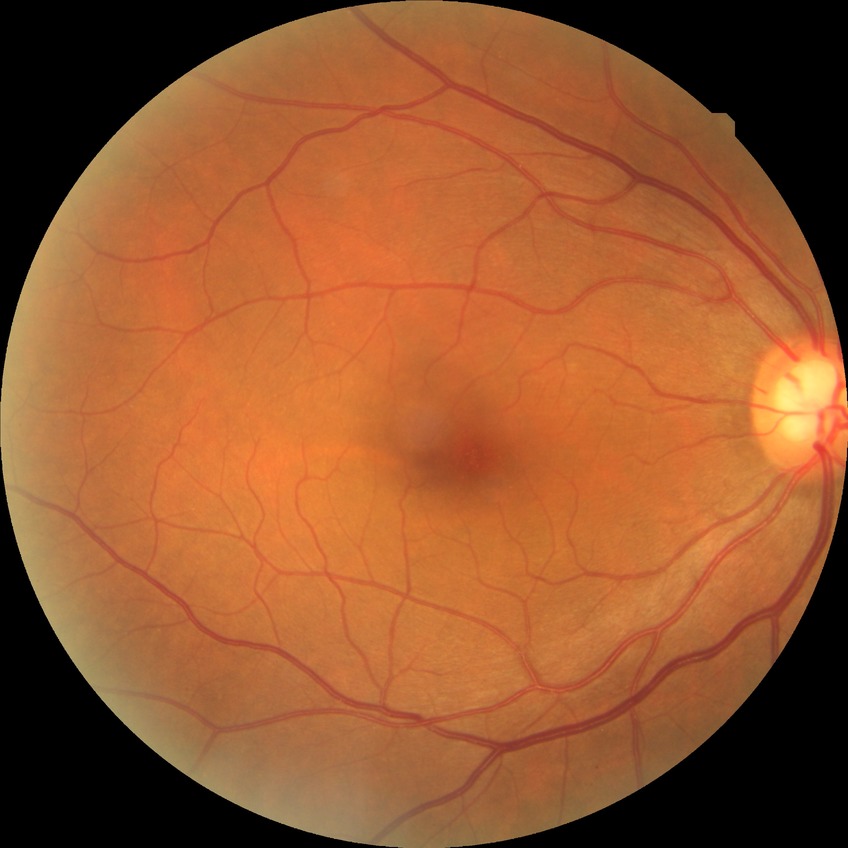 Findings:
* diabetic retinopathy (DR): no diabetic retinopathy (NDR)